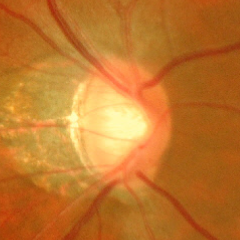

Demonstrates advanced glaucoma. Defined as near-total cupping of the optic nerve head, with or without severe visual field loss within the central 10 degrees of fixation.